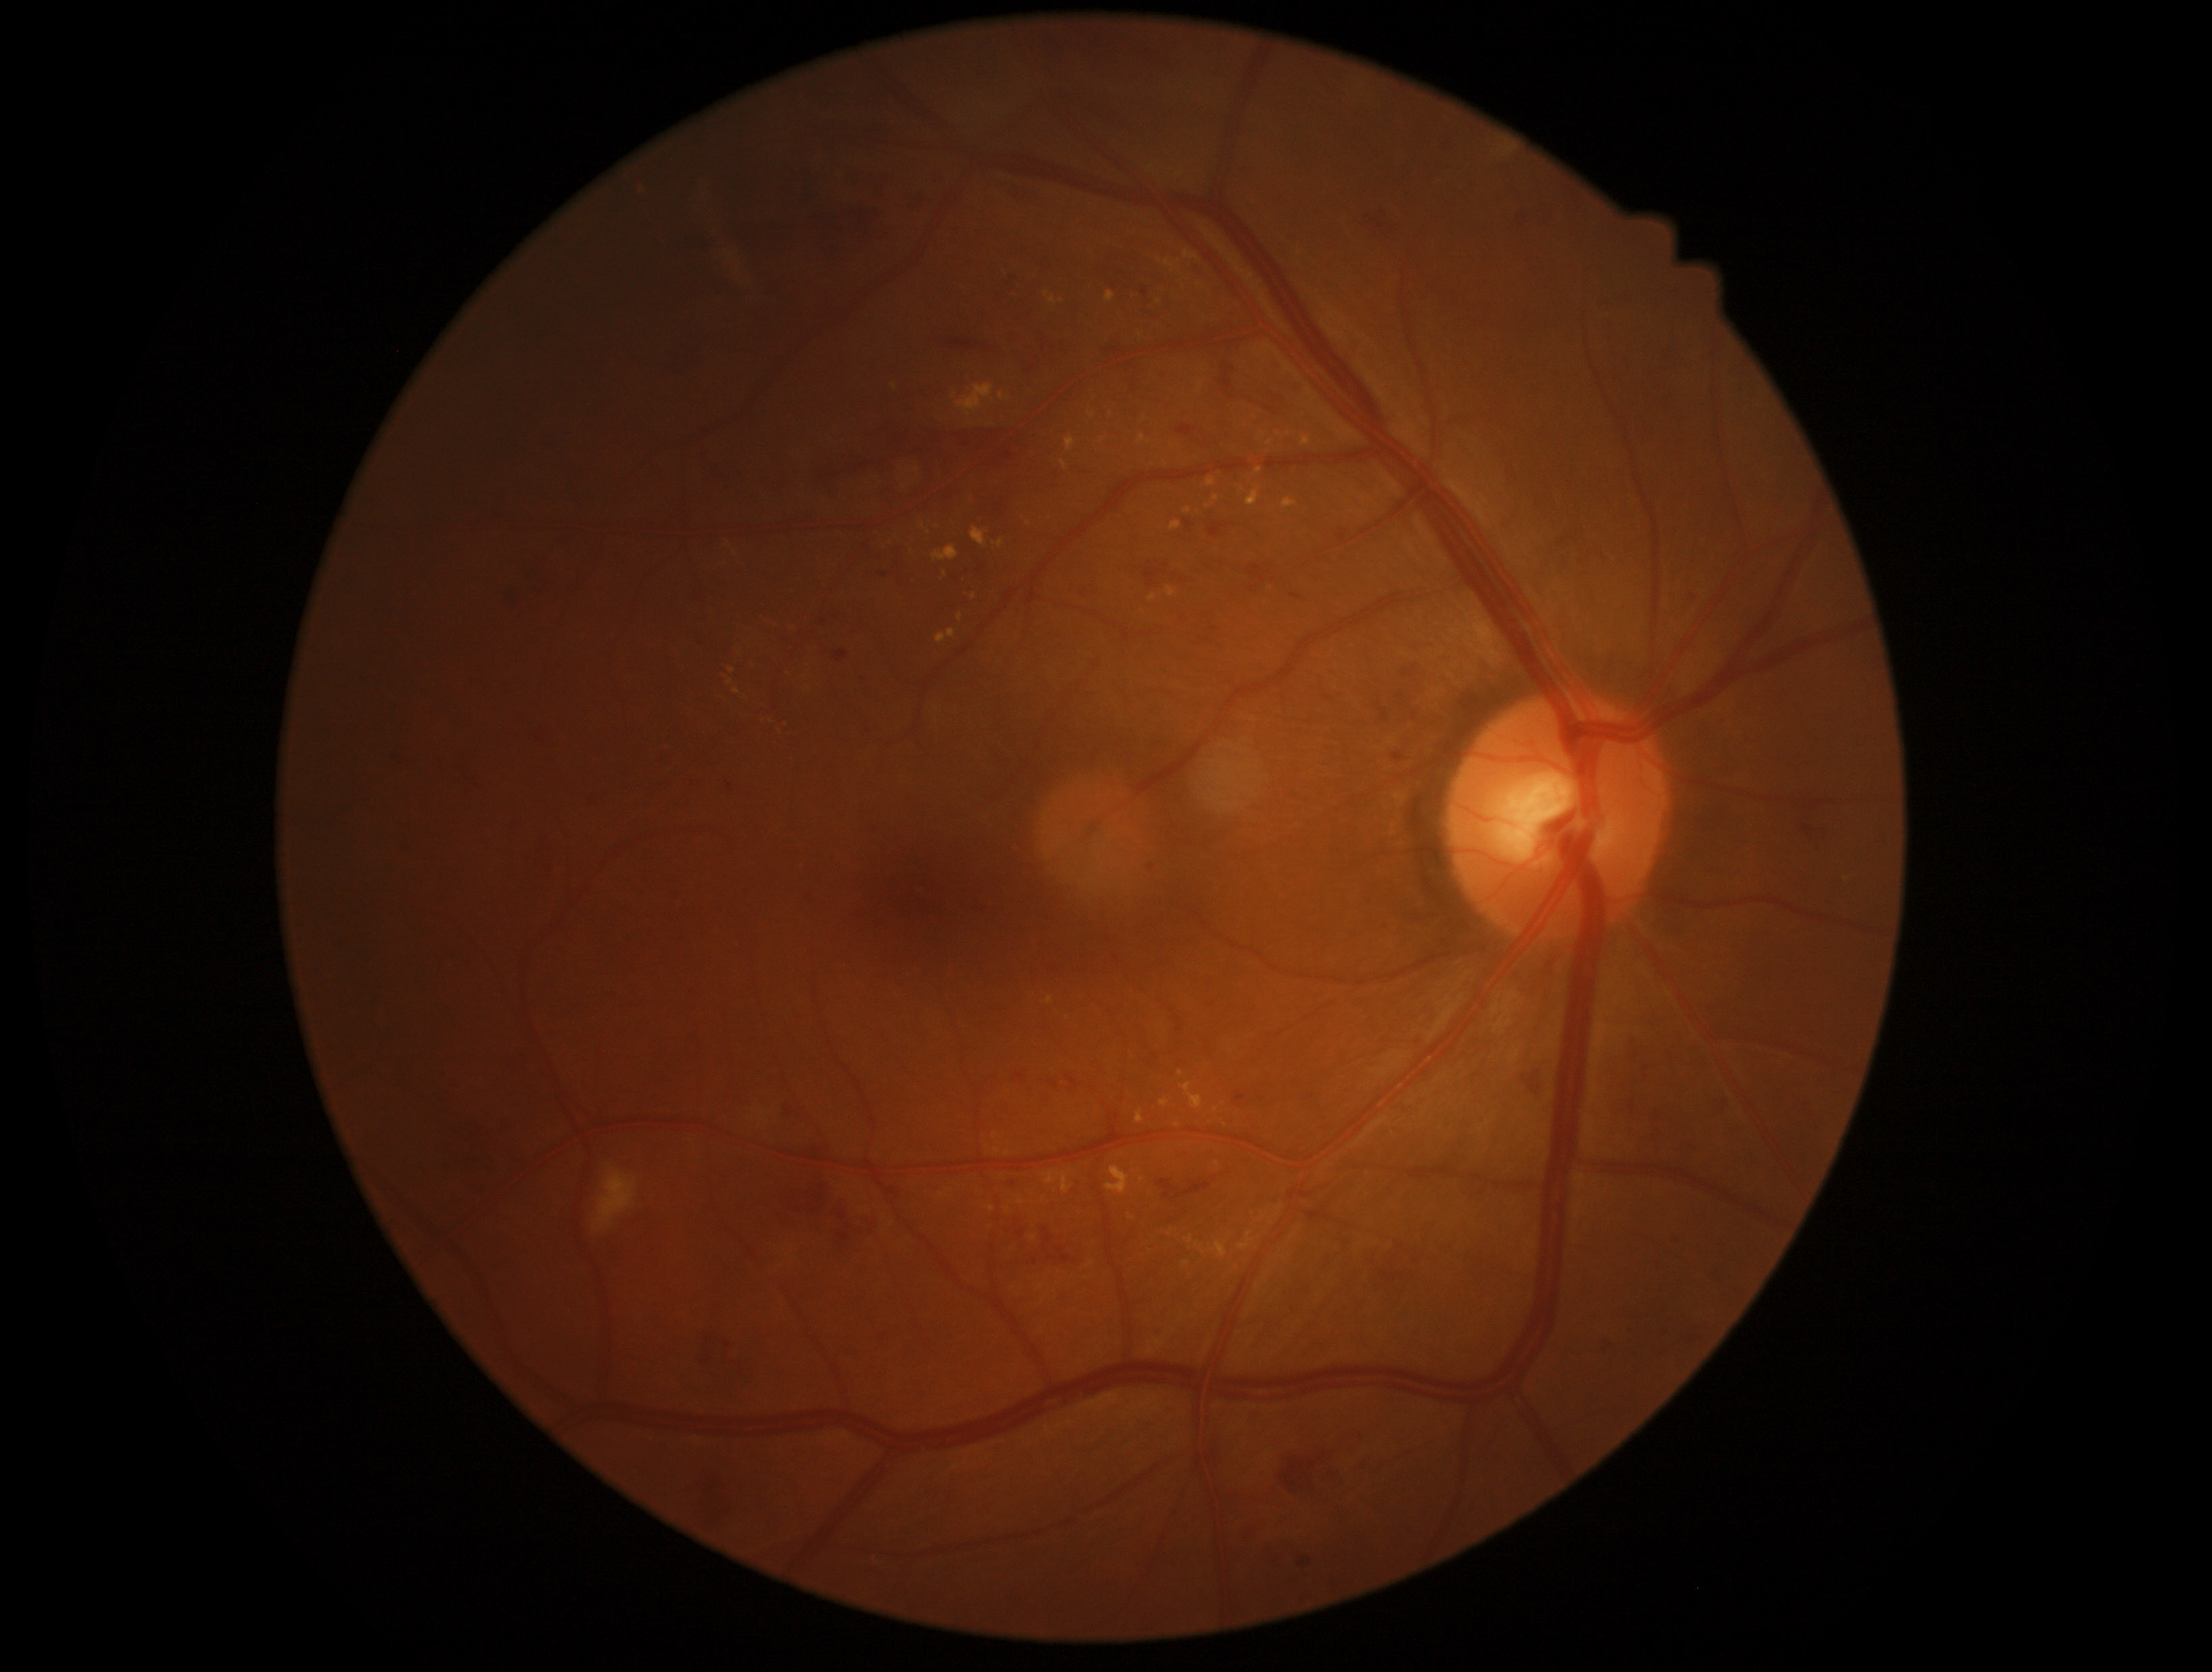

Retinopathy: 2 — more than just microaneurysms but less than severe NPDR.